Fundus photo, diabetic retinopathy graded by the modified Davis classification.
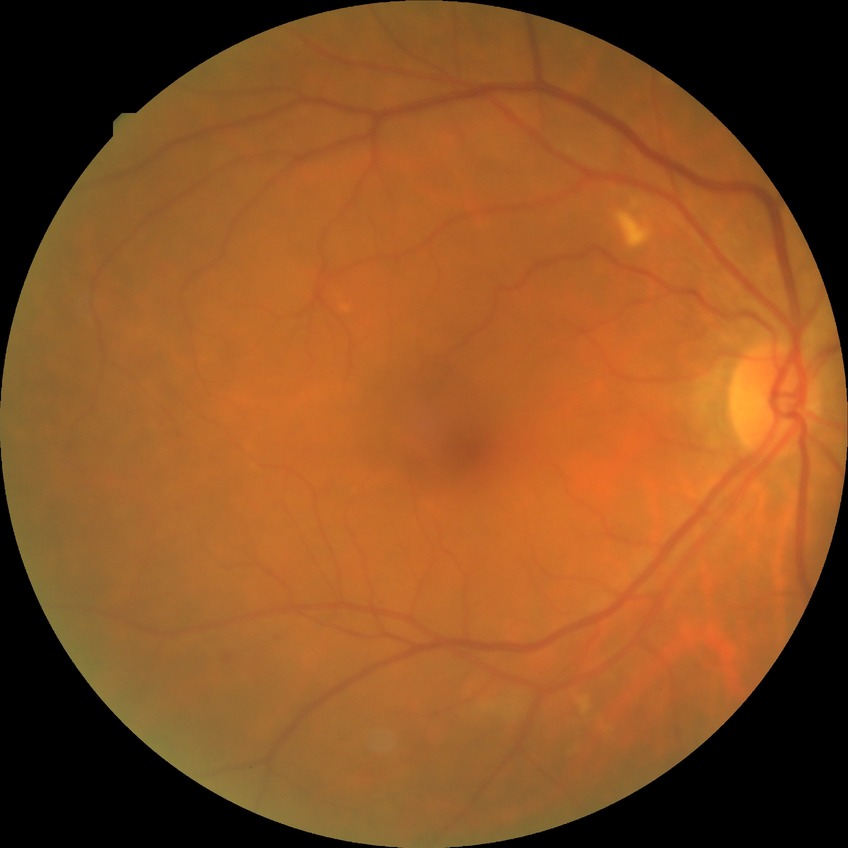

Diabetic retinopathy (DR) is SDR (simple diabetic retinopathy). The retinopathy is classified as non-proliferative diabetic retinopathy.